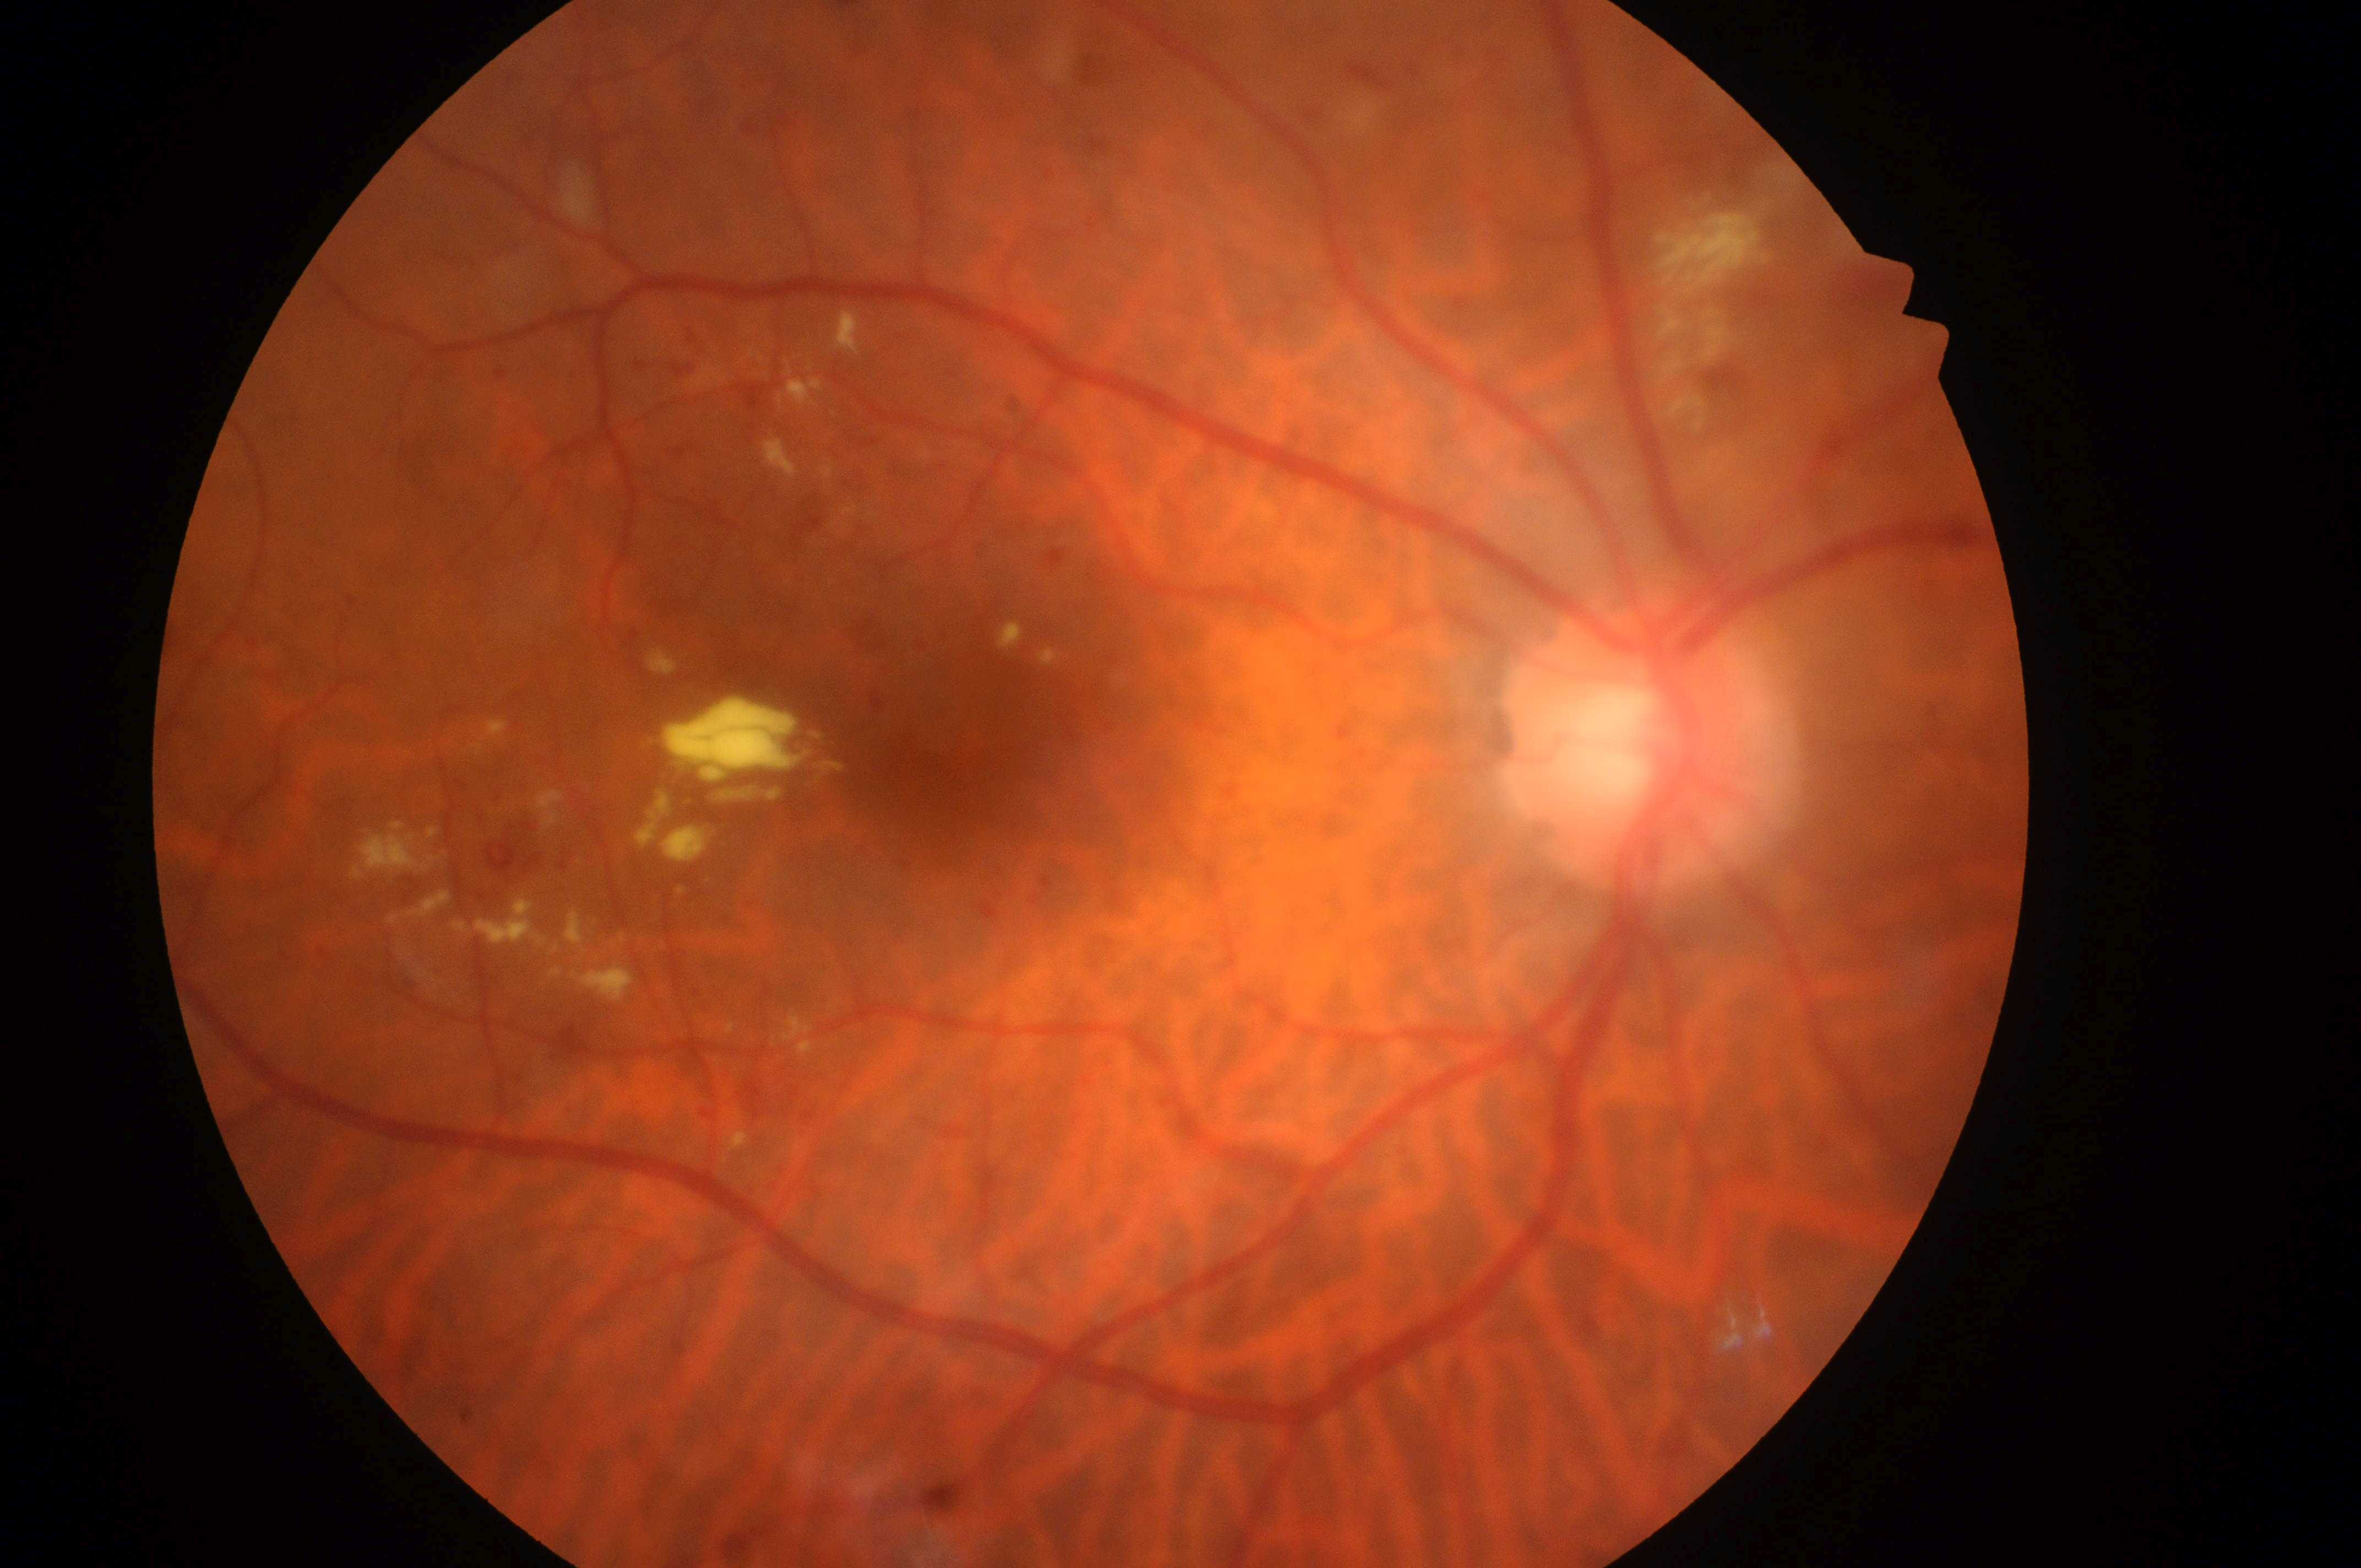 DR is 2/4.
DME risk: grade 2.
Optic disc: (x=1638, y=748).
Fovea centralis located at (x=953, y=767).
The image shows the oculus dexter.